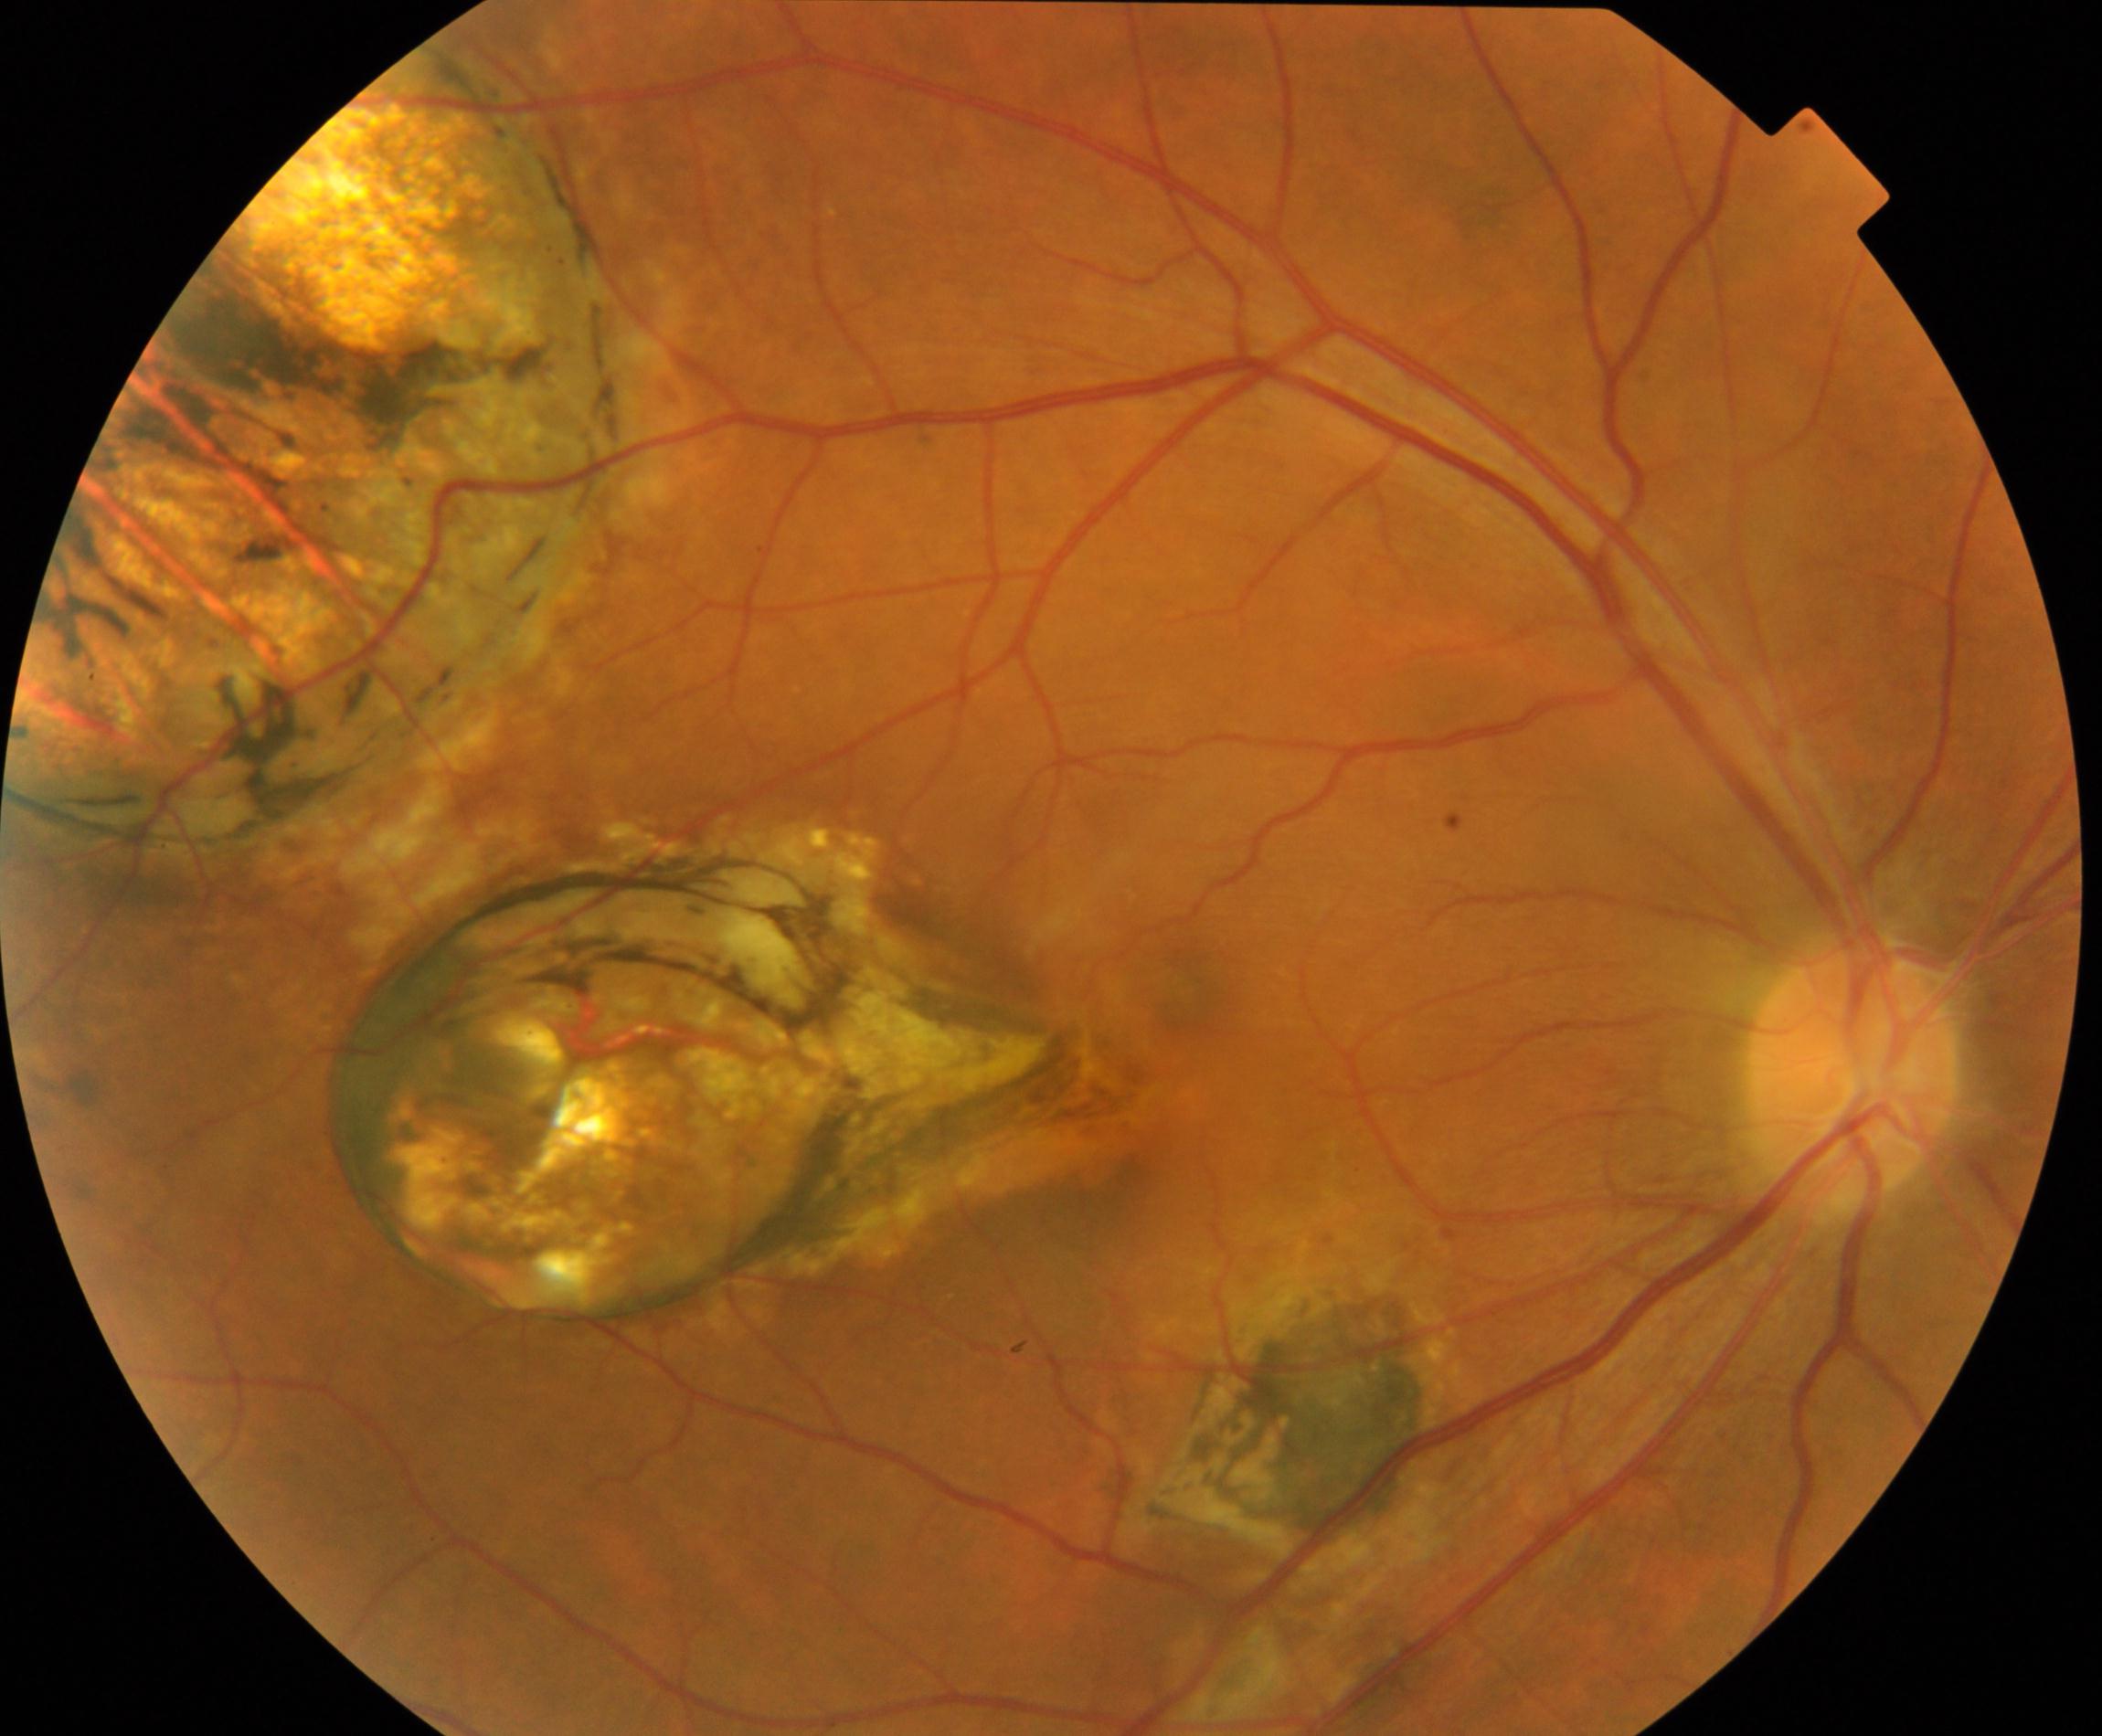 Findings consistent with chorioretinal atrophy or coloboma. Typically showing focal or extensive retinal pigment epithelium and choroidal atrophy or coloboma.